Acquired with a NIDEK AFC-230: 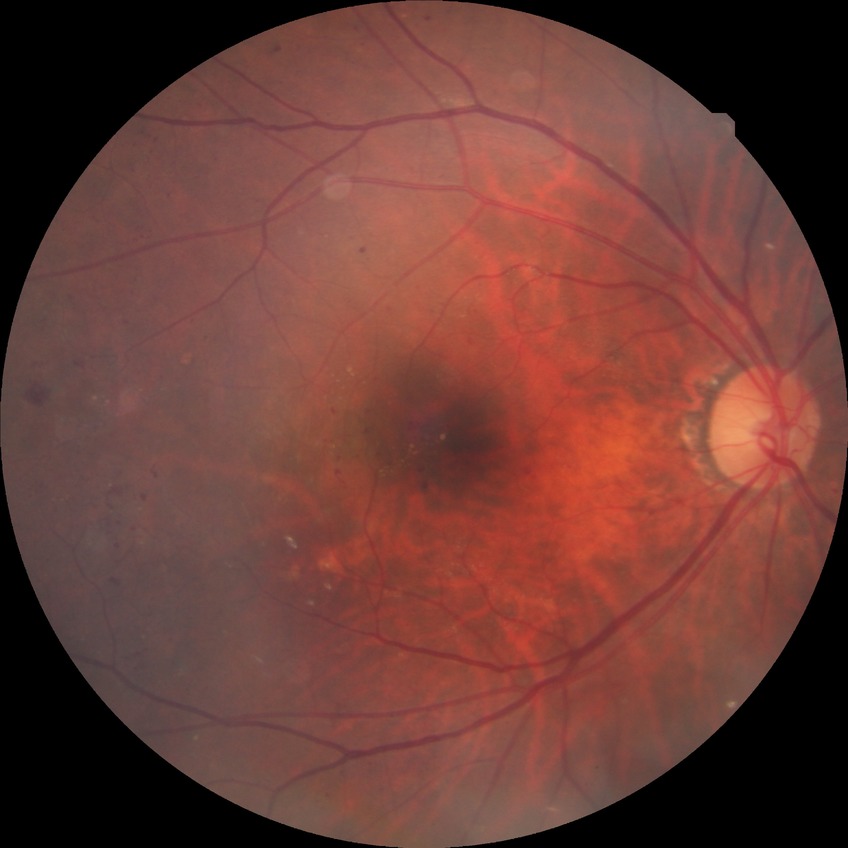

Diabetic retinopathy severity is proliferative diabetic retinopathy.